2048x1536px.
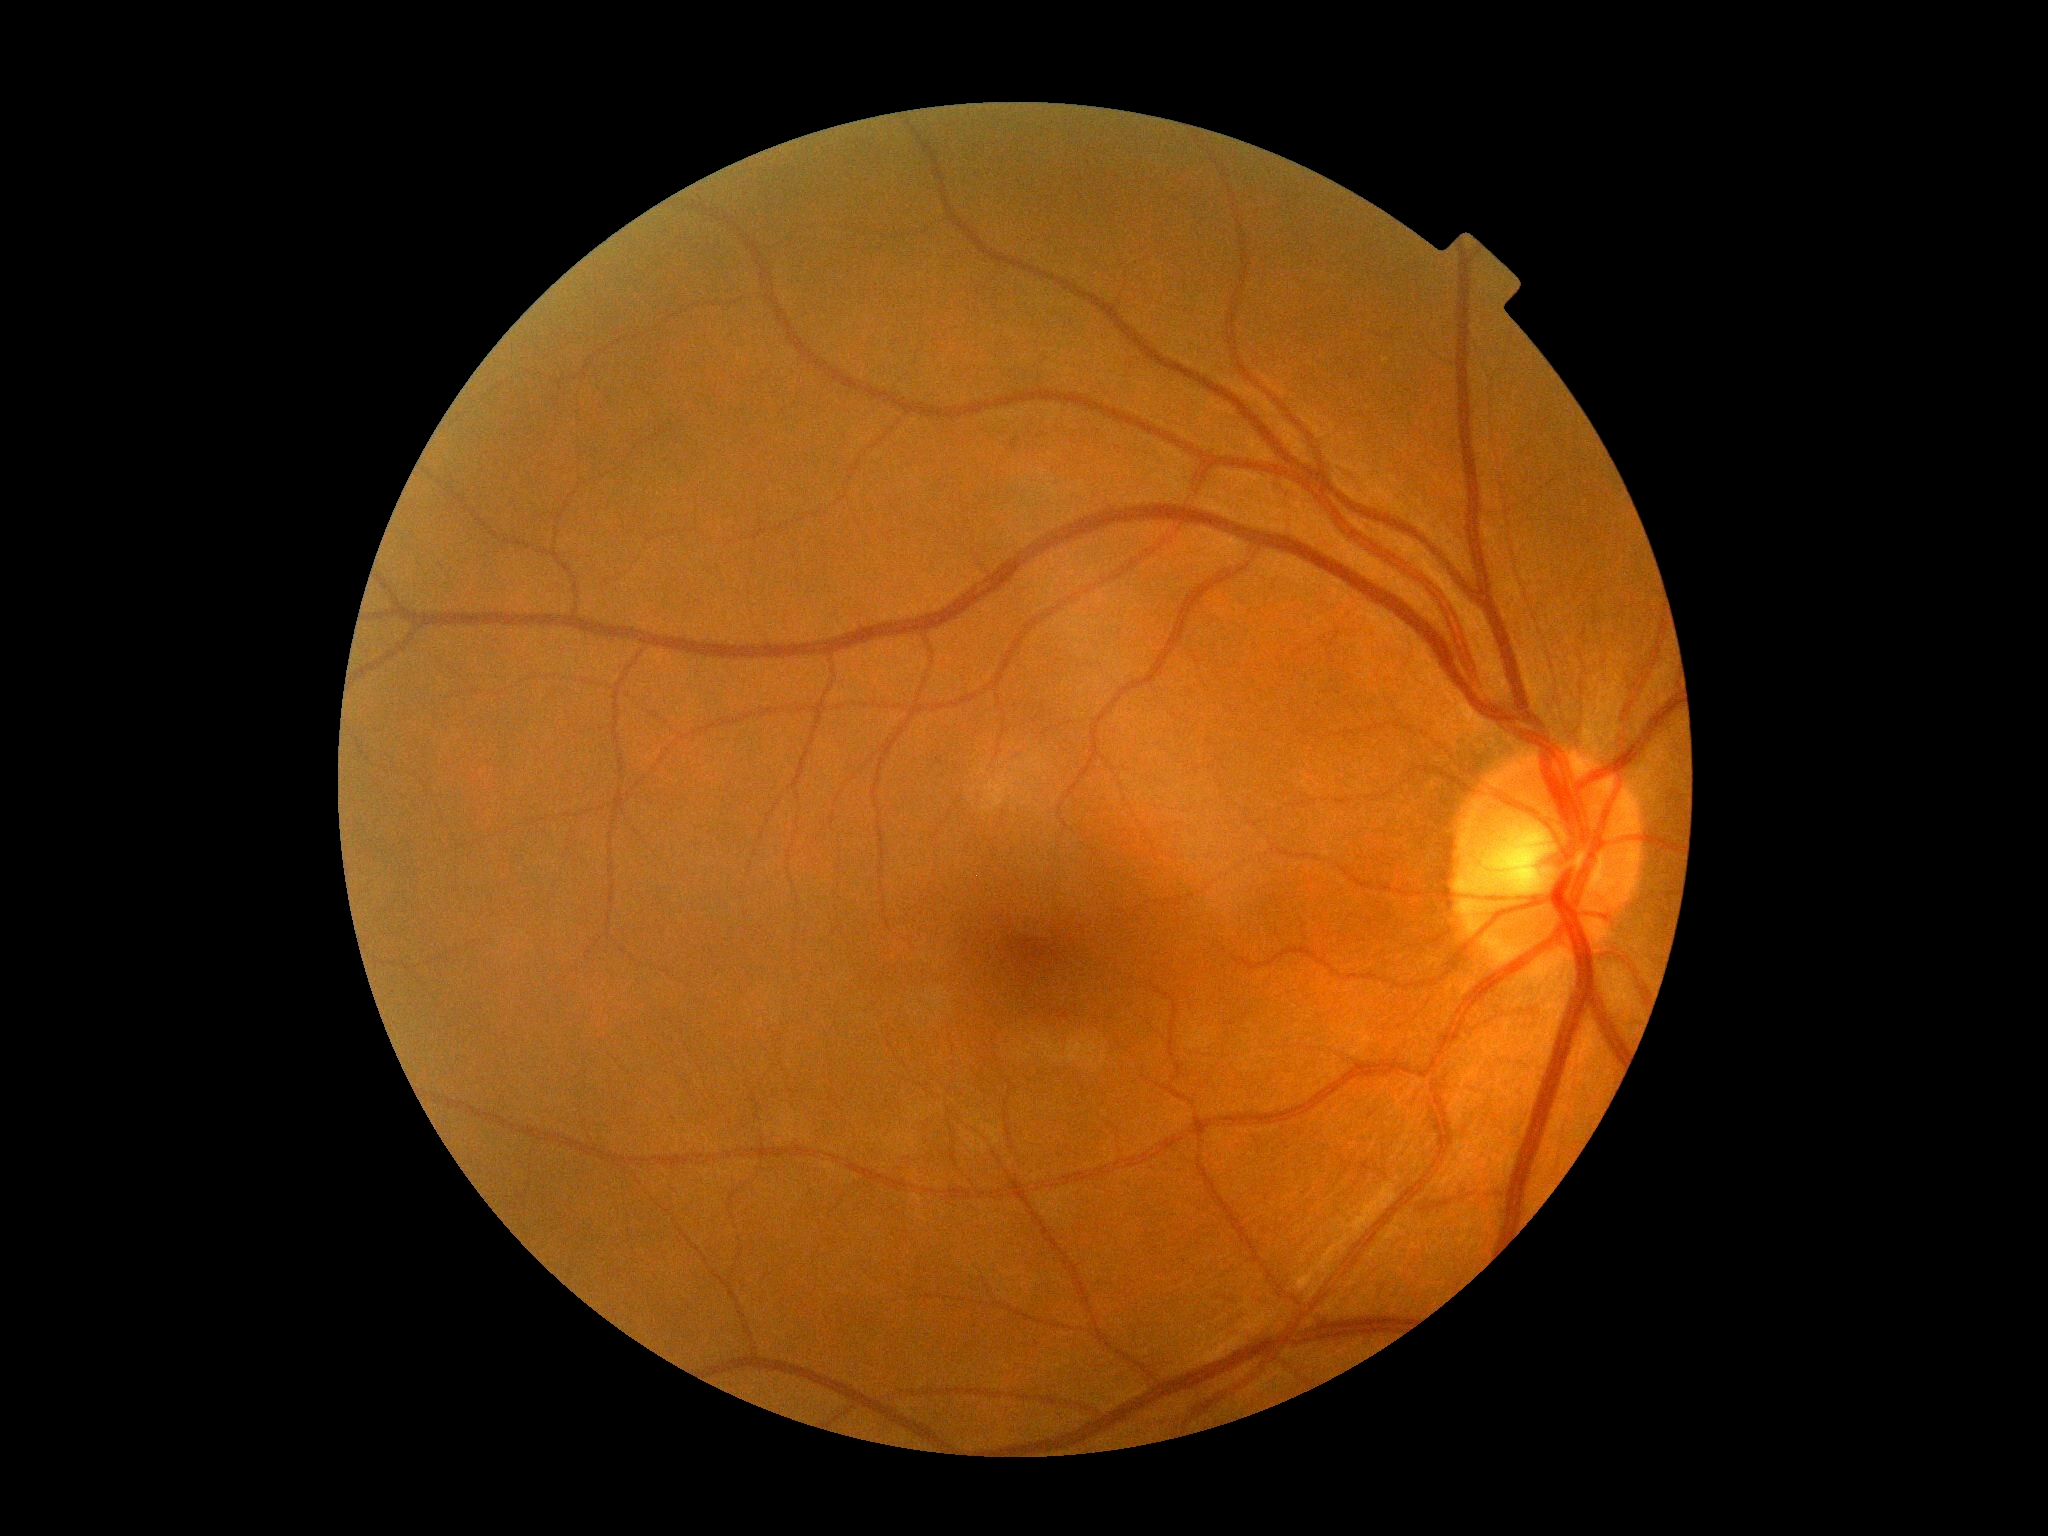
dr_grade: grade 0 (no apparent retinopathy)